45-degree field of view · color fundus photograph · image size 2048x1536: 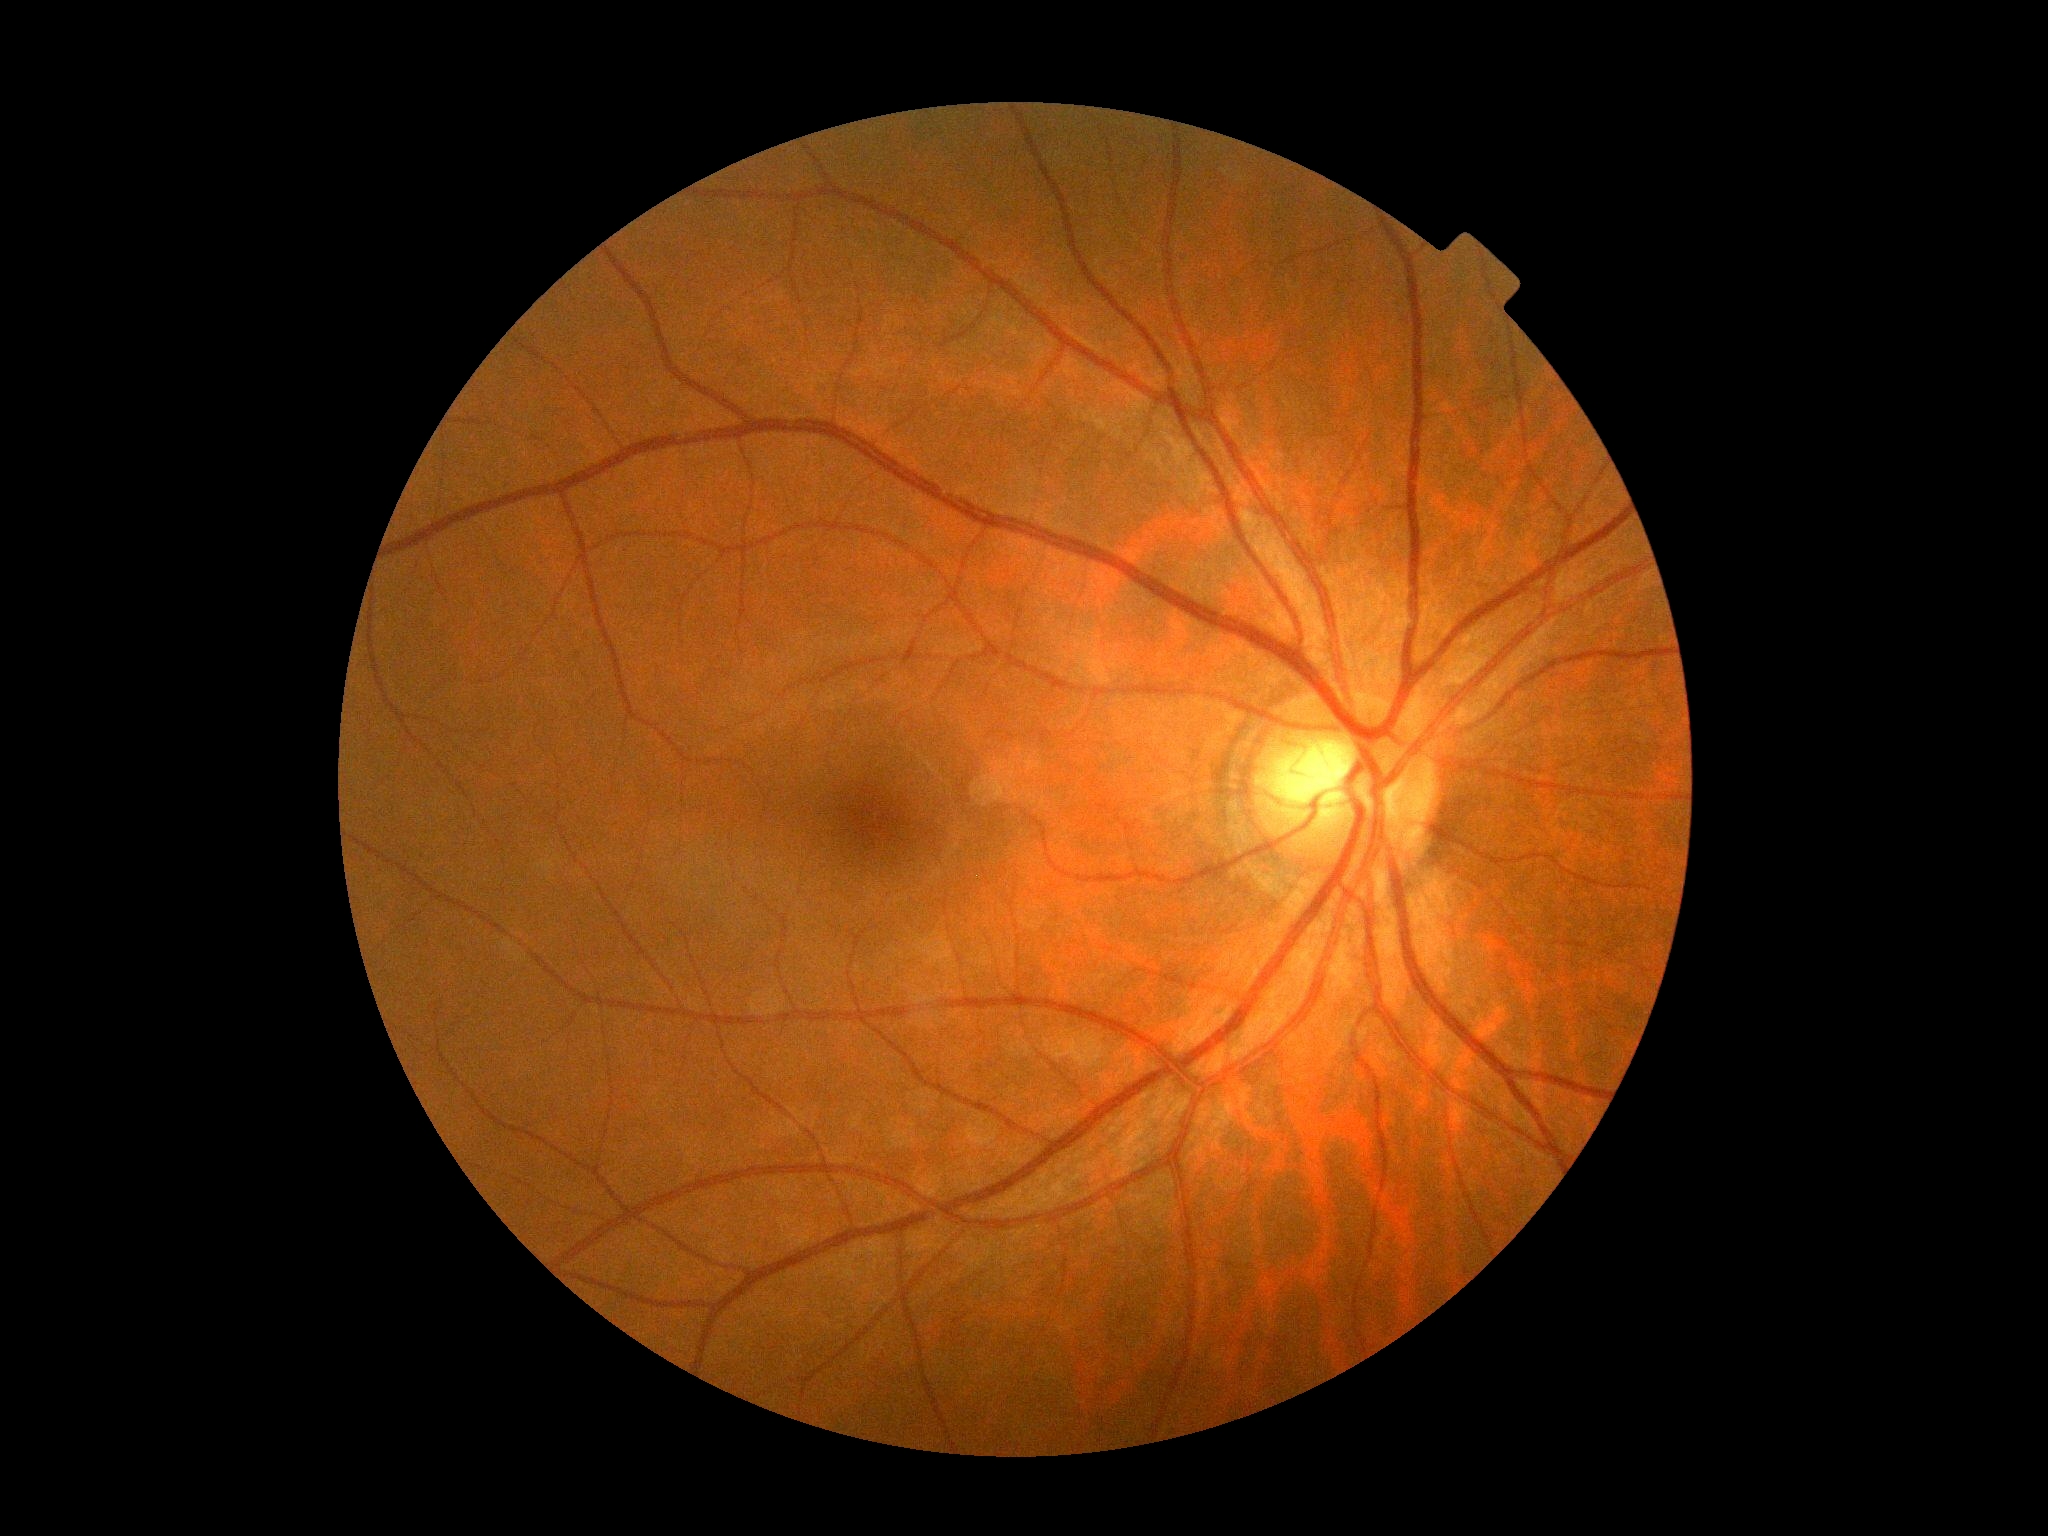 retinopathy=grade 0 (no apparent retinopathy) — no visible signs of diabetic retinopathy.